FOV: 45 degrees. 2184 by 1690 pixels. Fundus photo — 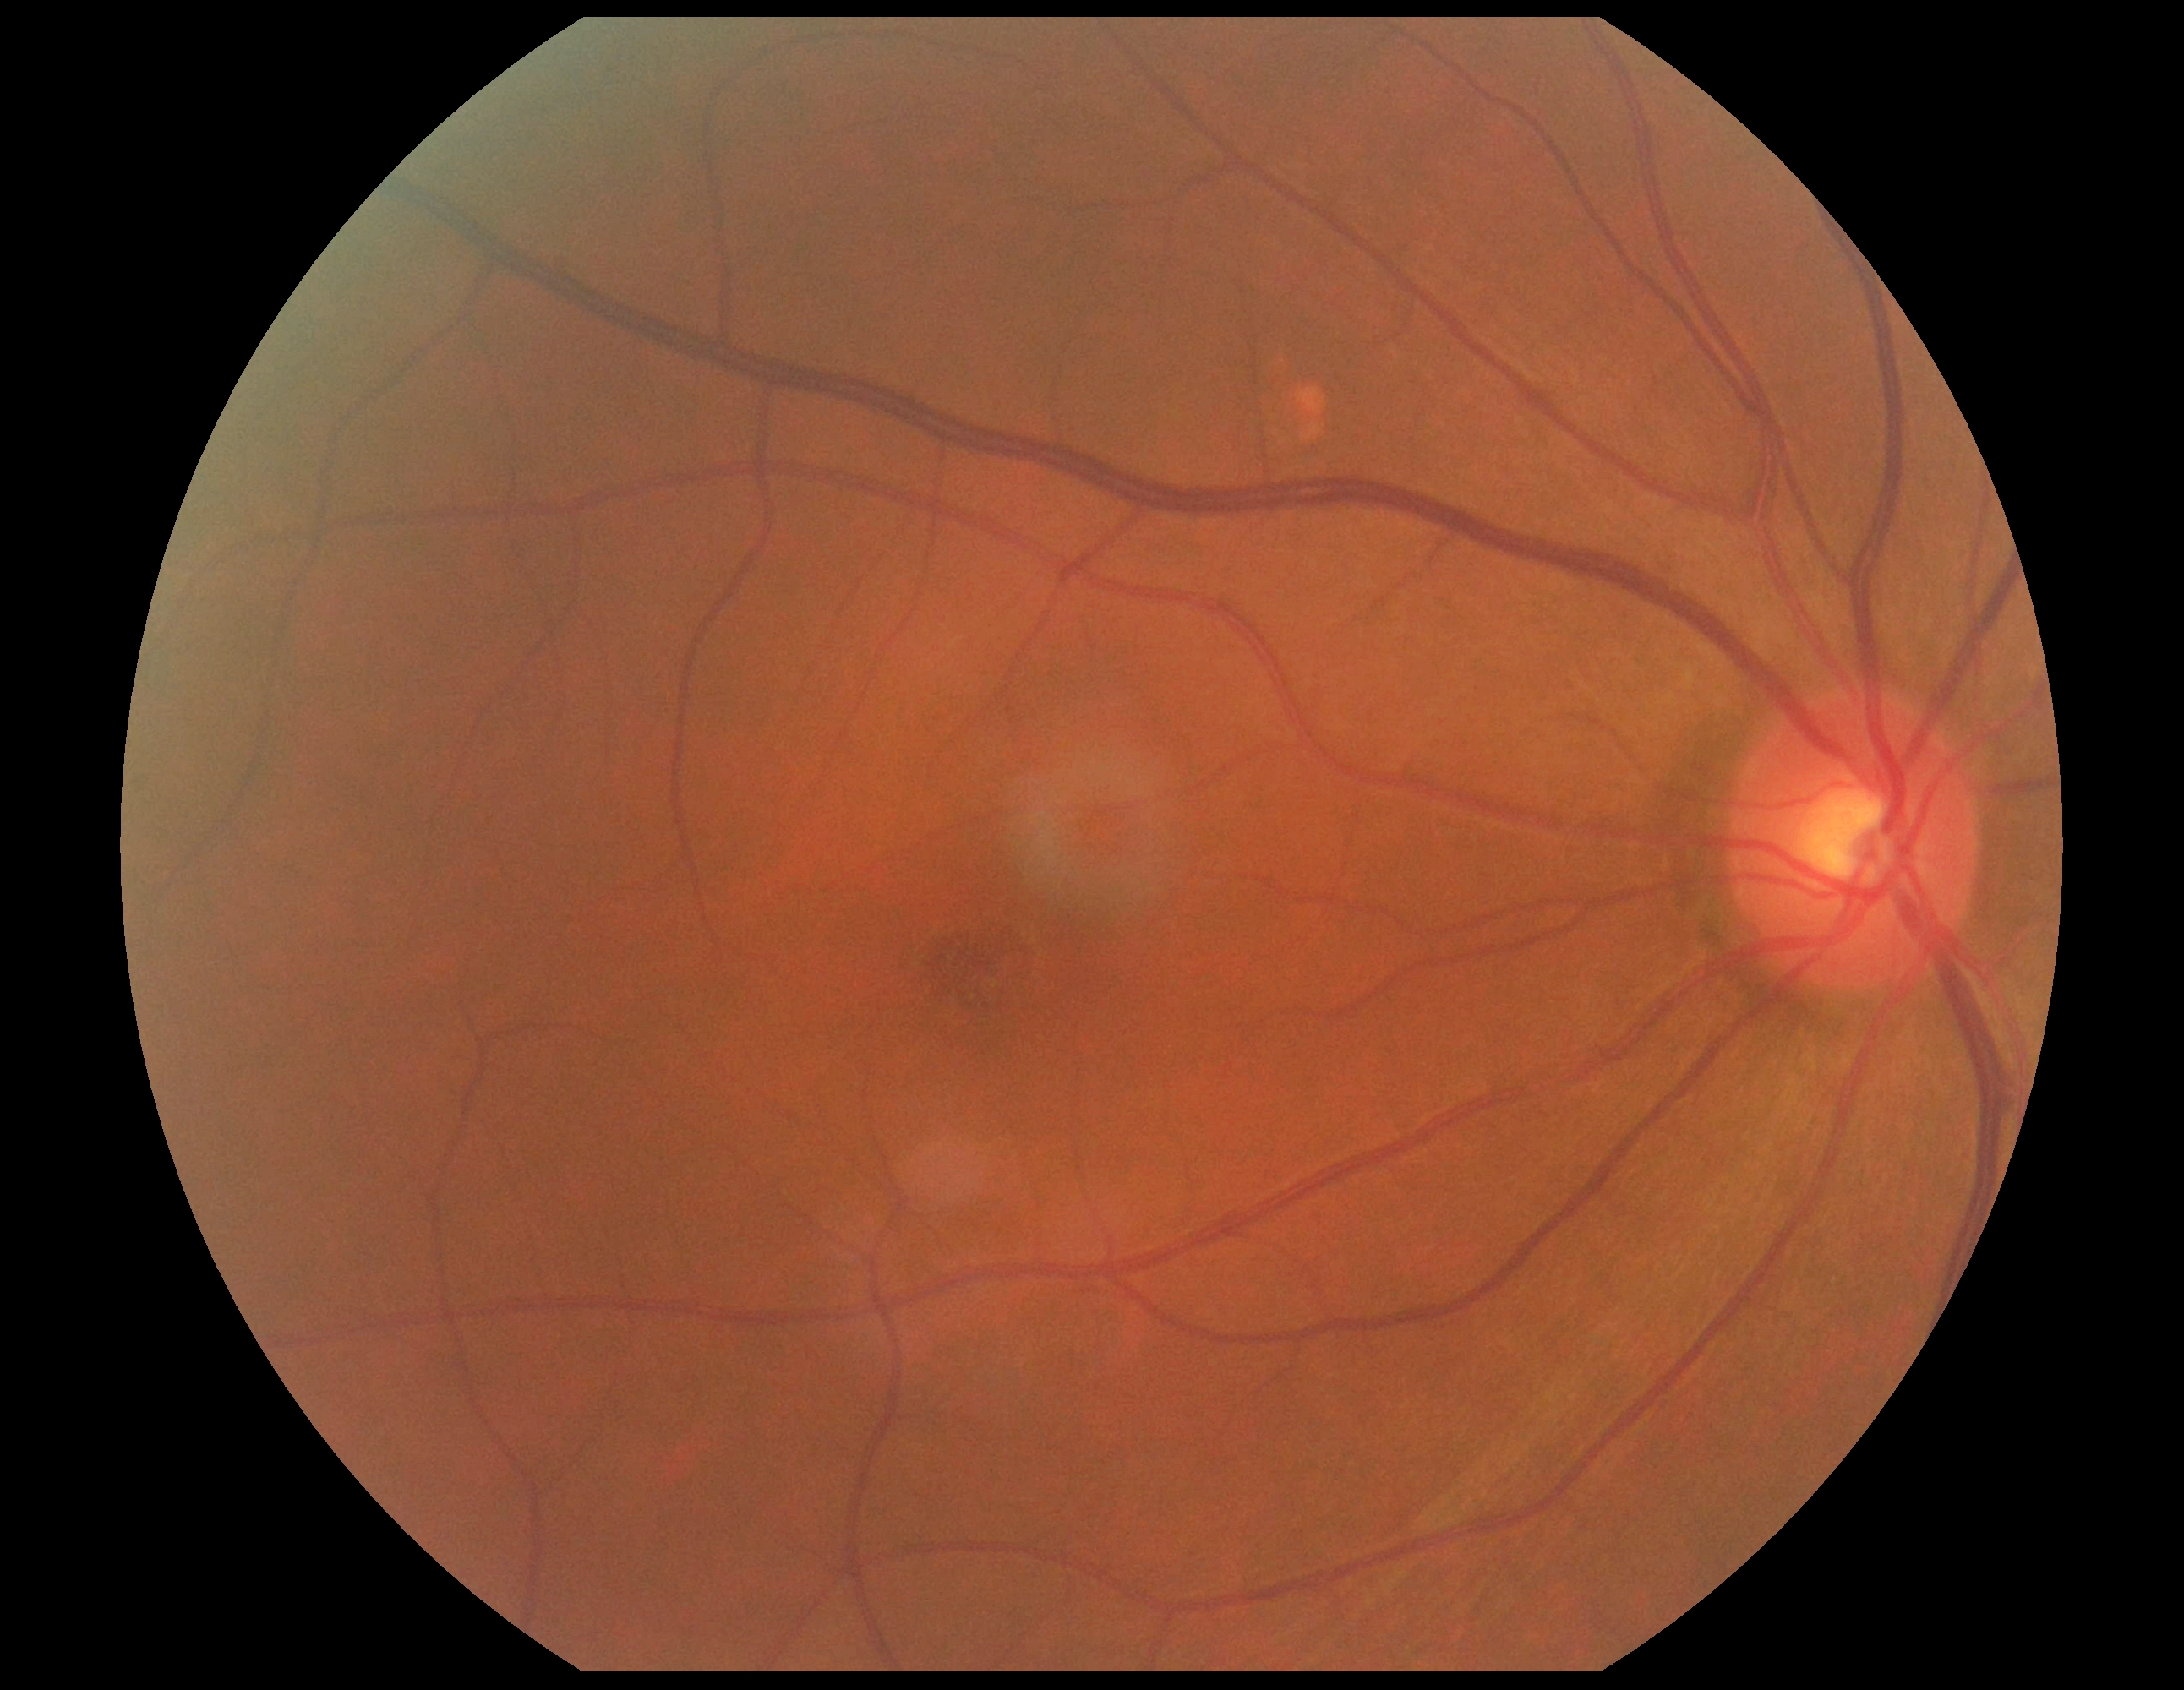
DR impression: no DR findings; retinopathy grade: 0 (no apparent retinopathy).